2212x1659
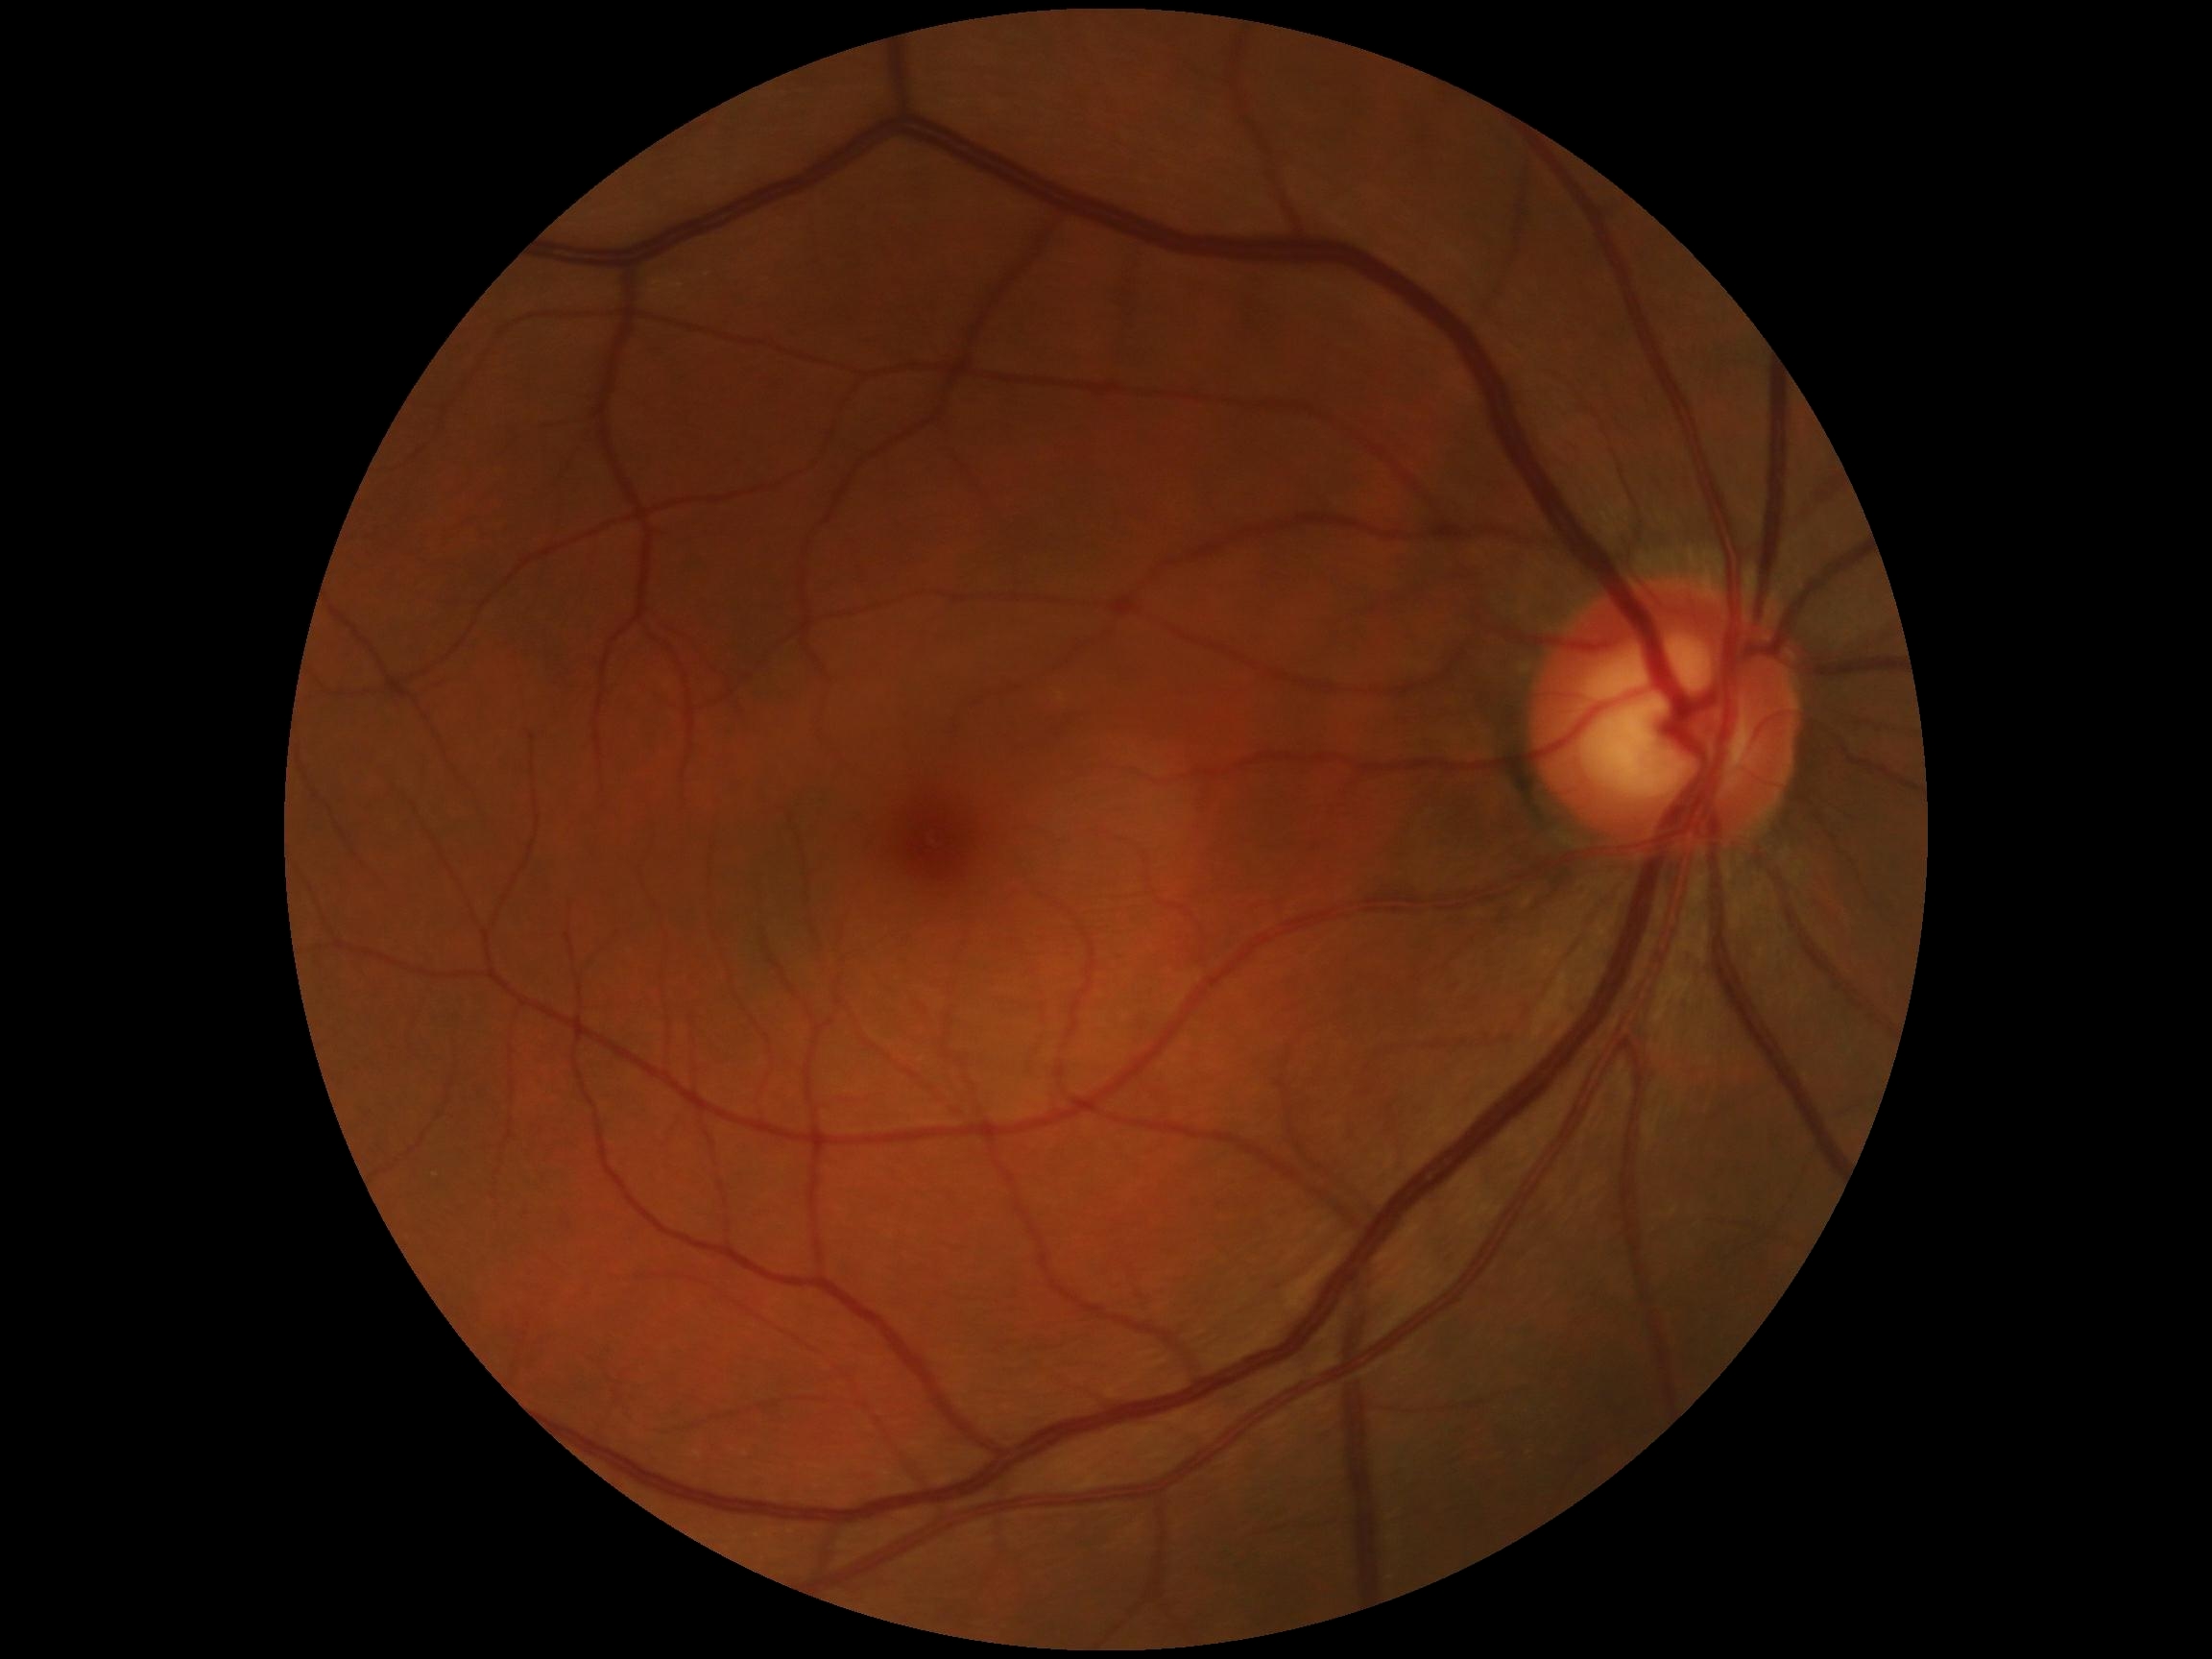
DR stage: grade 0 (no apparent retinopathy).